Color fundus photograph: 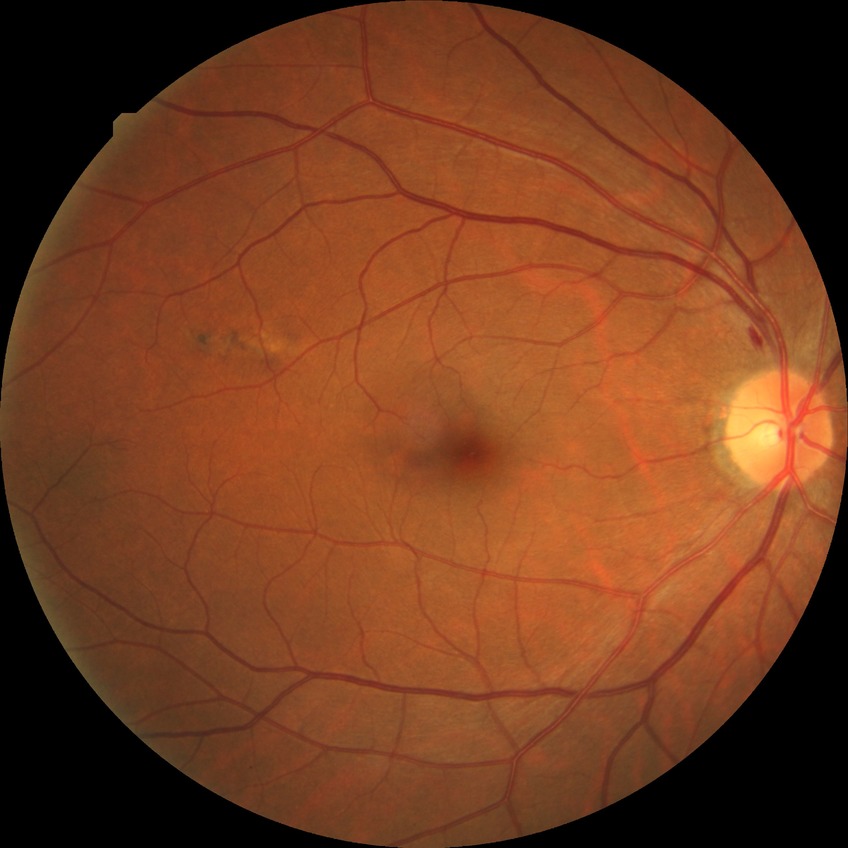
Davis grading: simple diabetic retinopathy.